1380 x 1382 pixels.
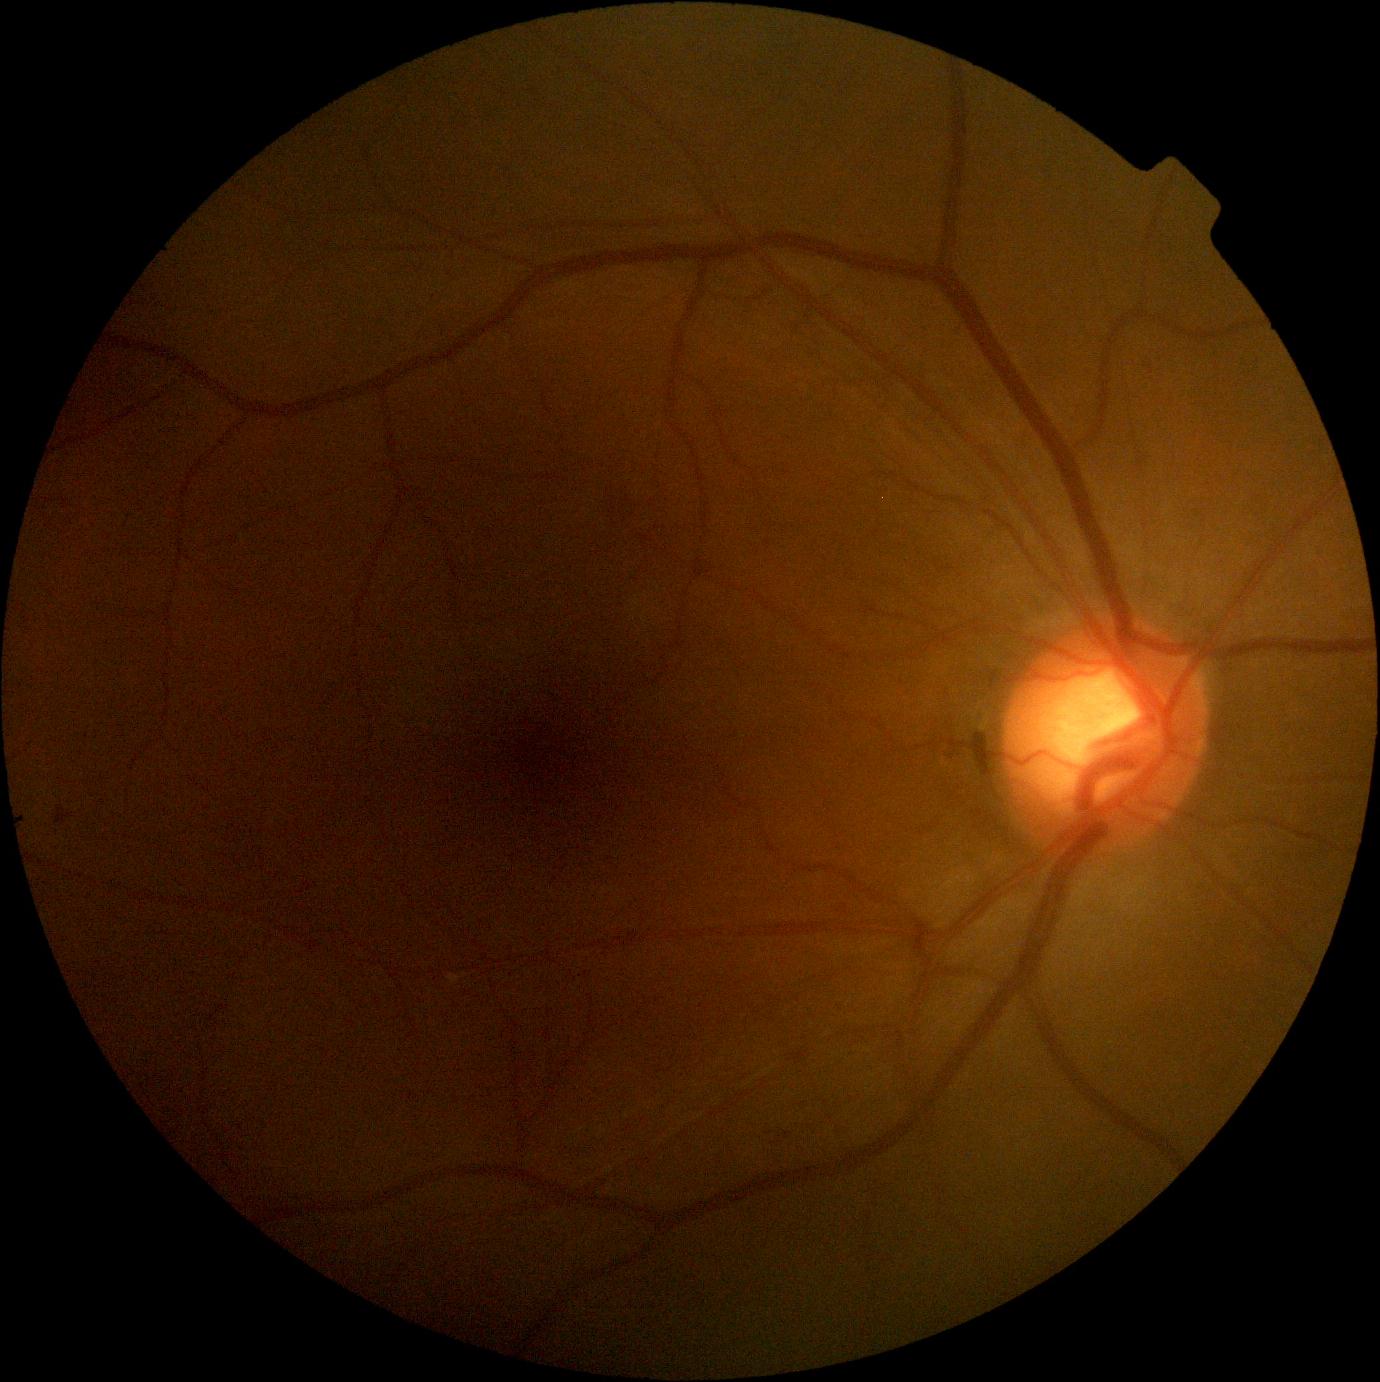 DR stage is moderate NPDR (grade 2).